Color fundus image, 50-degree field of view.
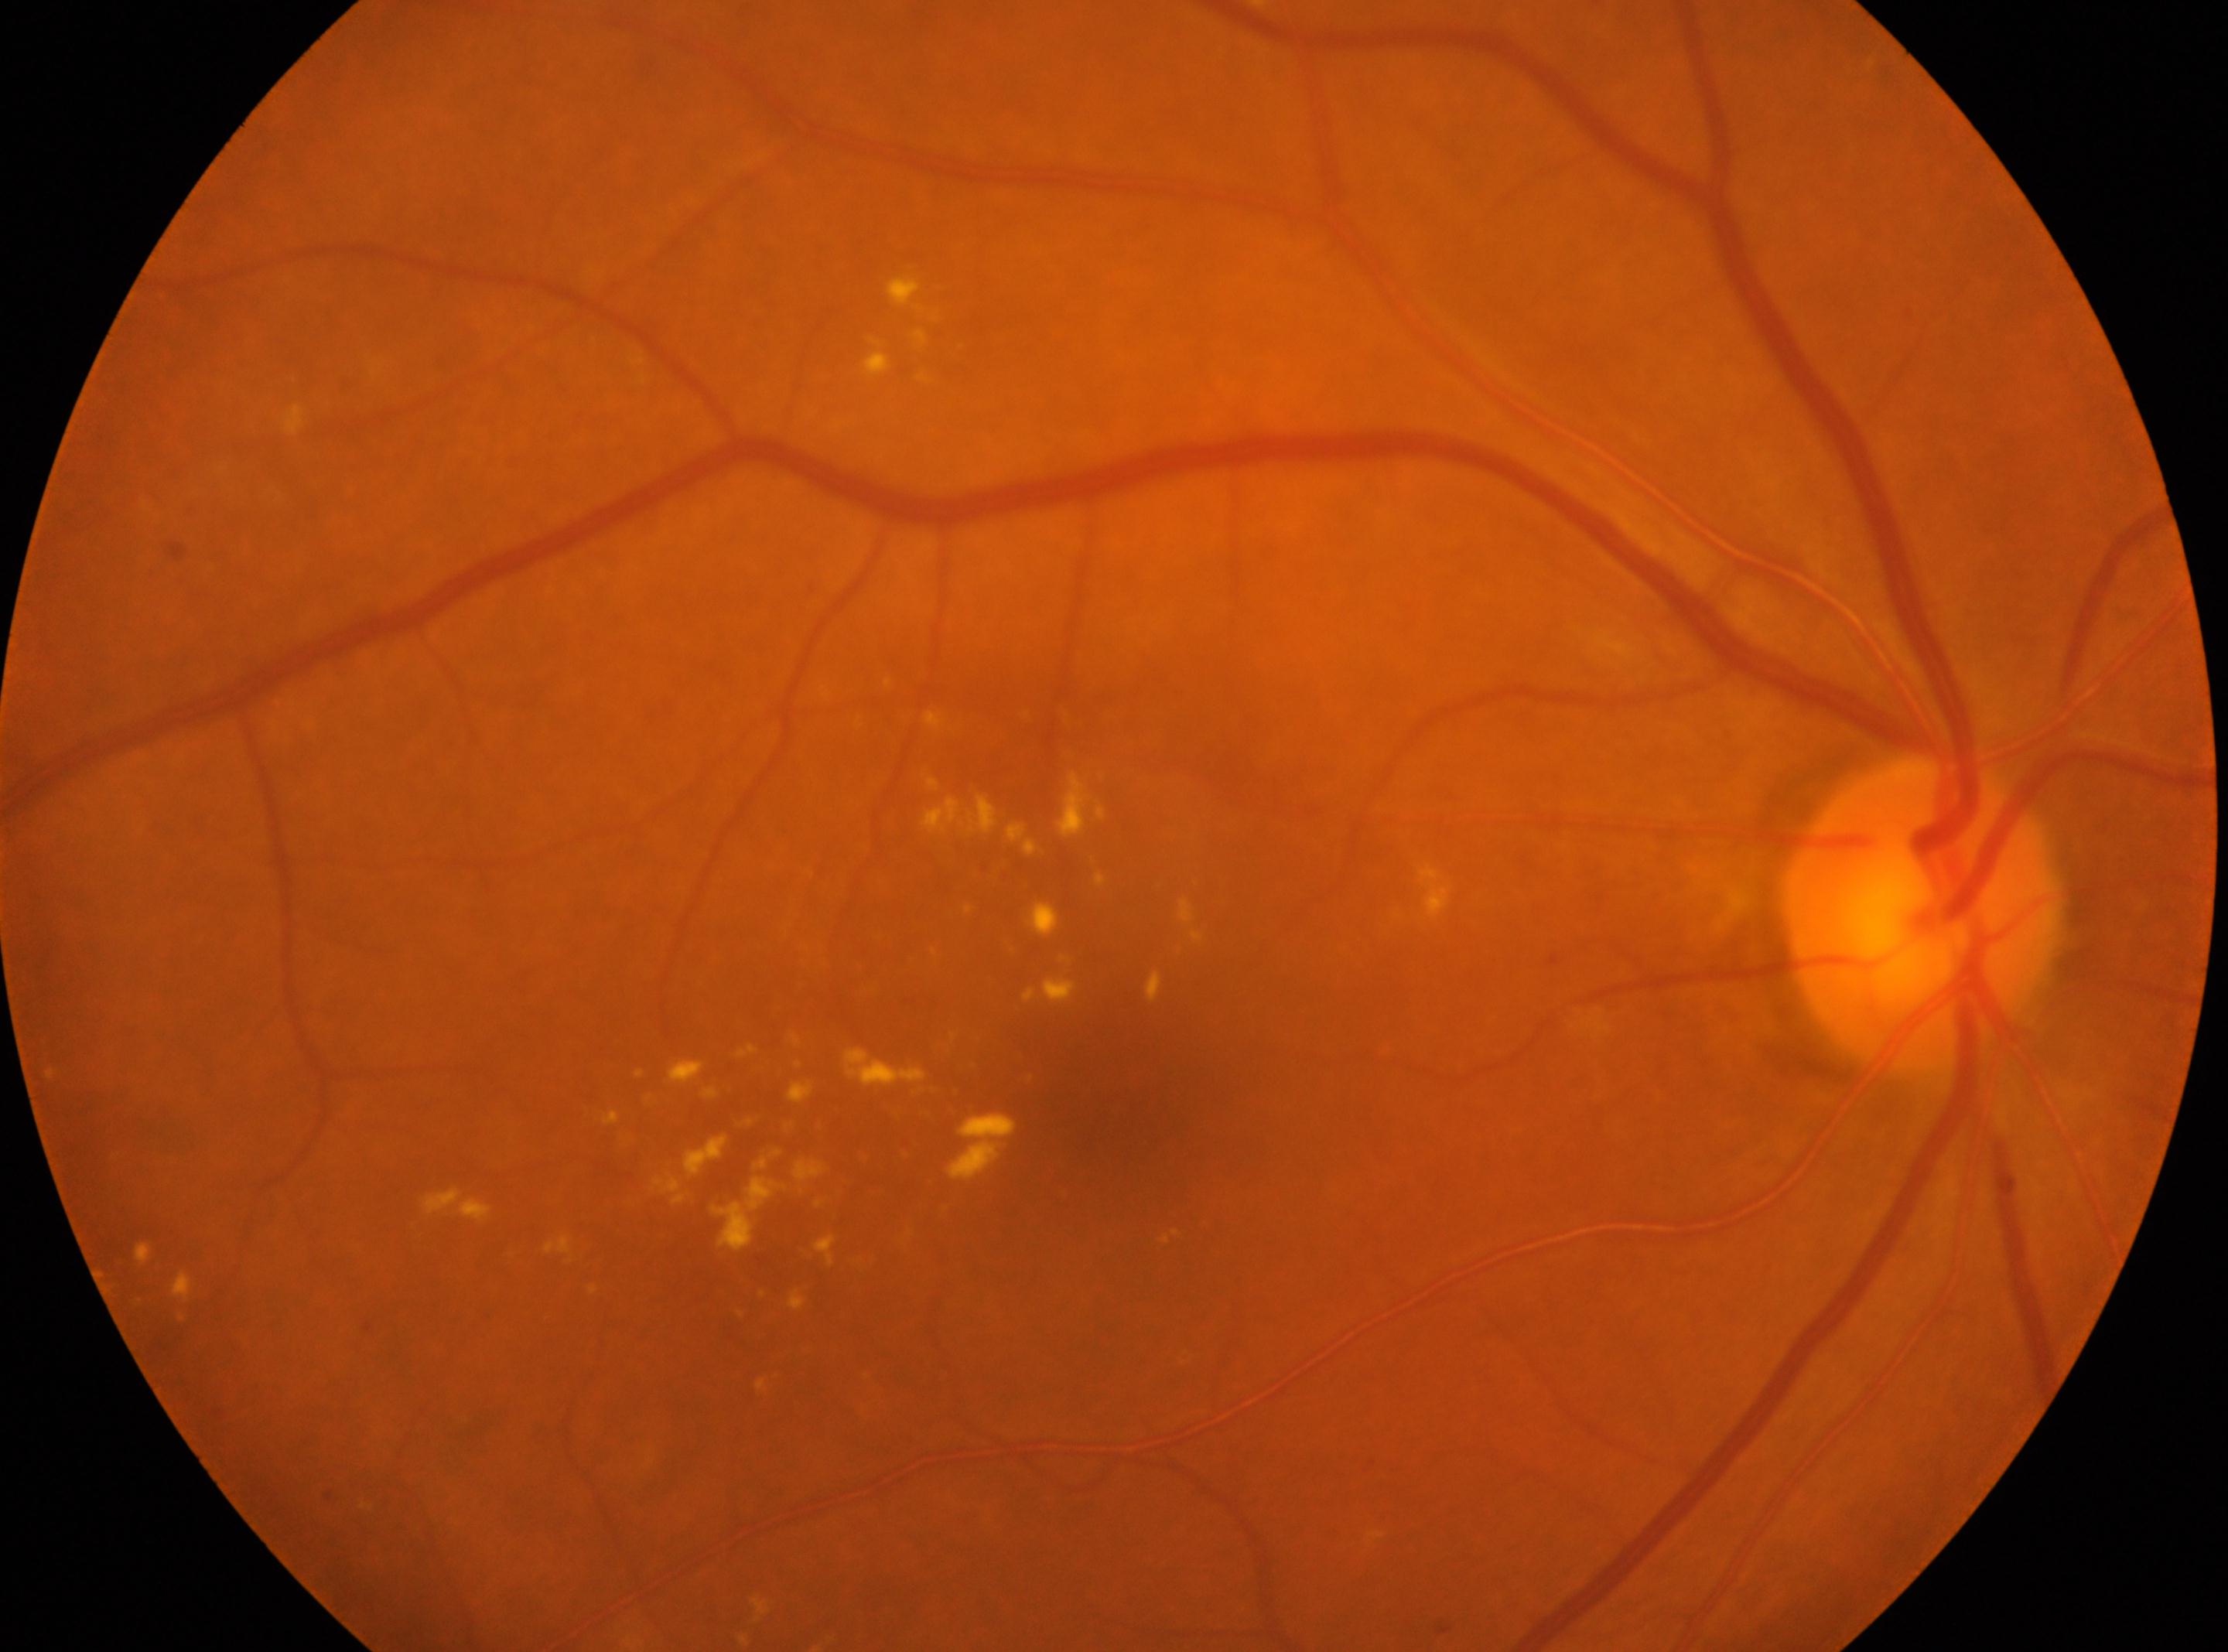 The fovea is at [1125, 1097]. ONH: [1922, 913]. Imaged eye: right eye. Diabetic retinopathy (DR): 2. The retinopathy is classified as non-proliferative diabetic retinopathy.